Modified Davis classification · posterior pole color fundus photograph · image size 848x848 · no pharmacologic dilation
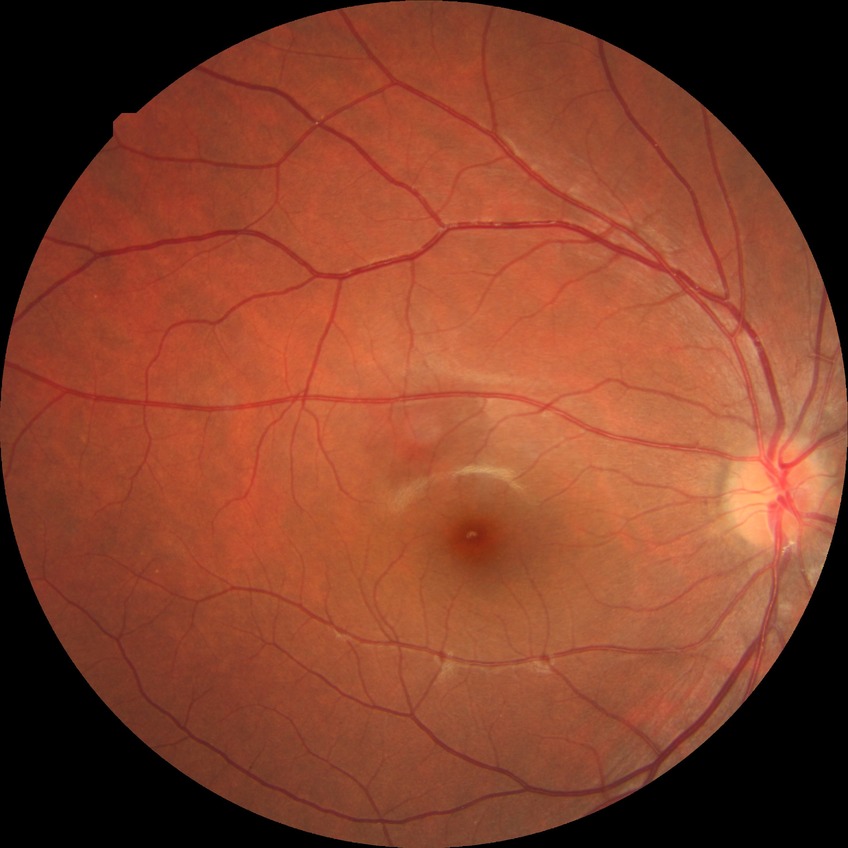 Modified Davis grading is no diabetic retinopathy.